Captured with the Phoenix ICON (100° field of view) · wide-field fundus photograph of an infant · image size 1240x1240: 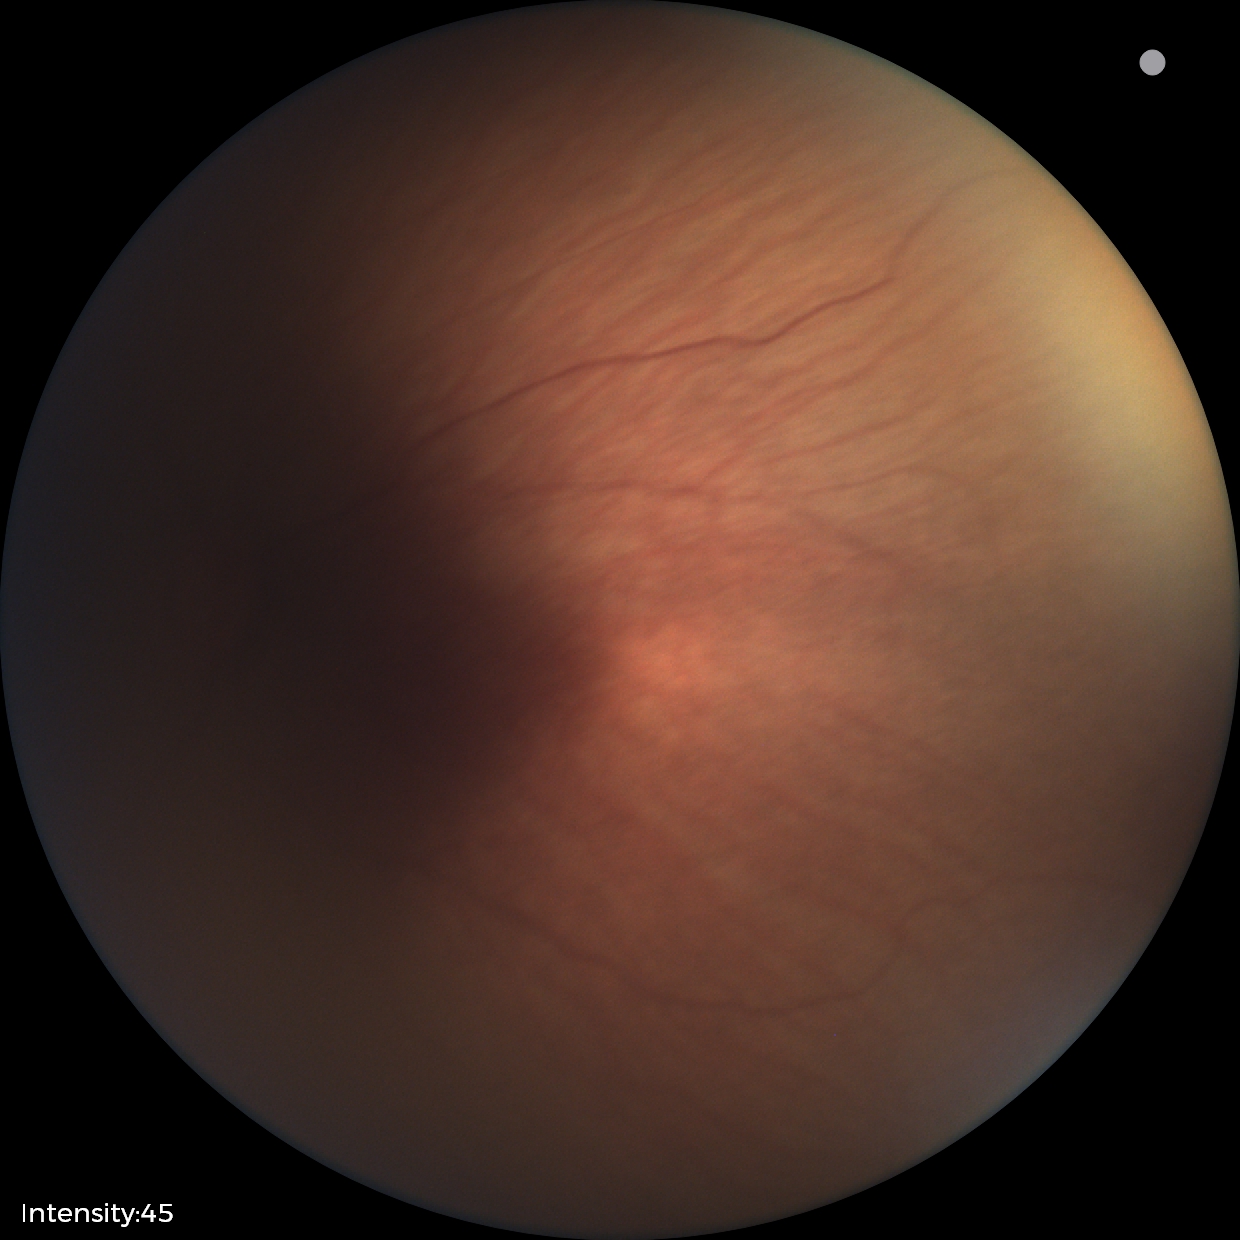
Finding: status post ROP, plus disease: absent.